Camera: Nidek AFC-330, CFP: 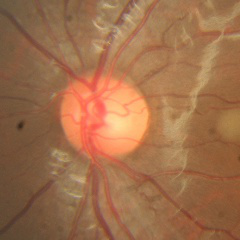
Glaucoma stage: no glaucoma.